Captured with the Clarity RetCam 3 (130° field of view); 640 by 480 pixels; infant wide-field retinal image.
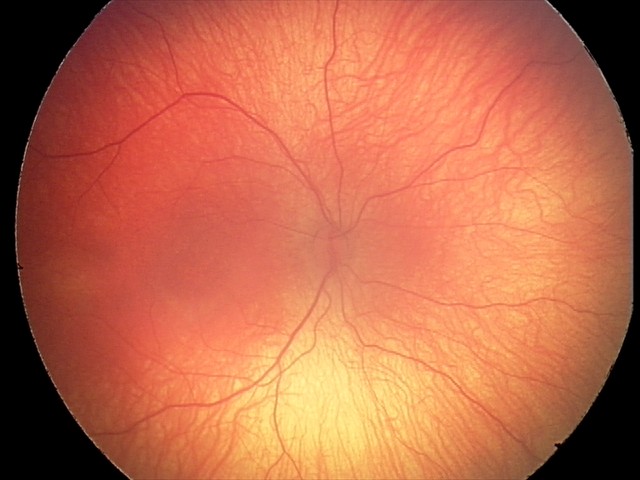

Screening series with retinopathy of prematurity stage 2 — ridge with height and width at the demarcation line. Without plus disease.